Nonmydriatic.
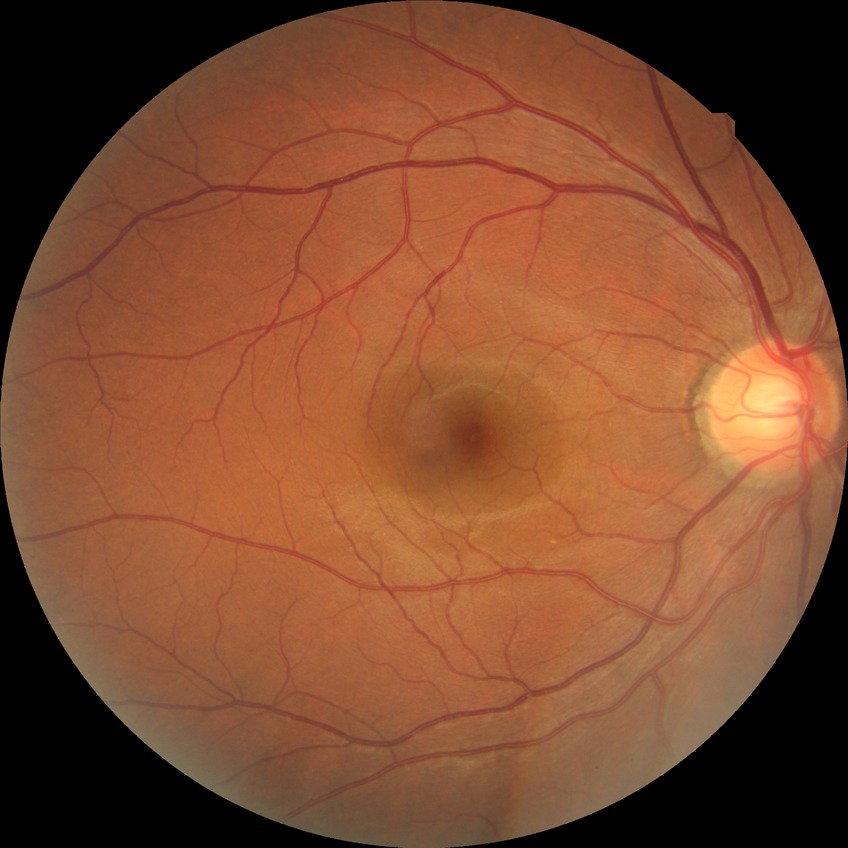
Davis DR grade is NDR.